Fundus photo; 848x848; nonmydriatic.
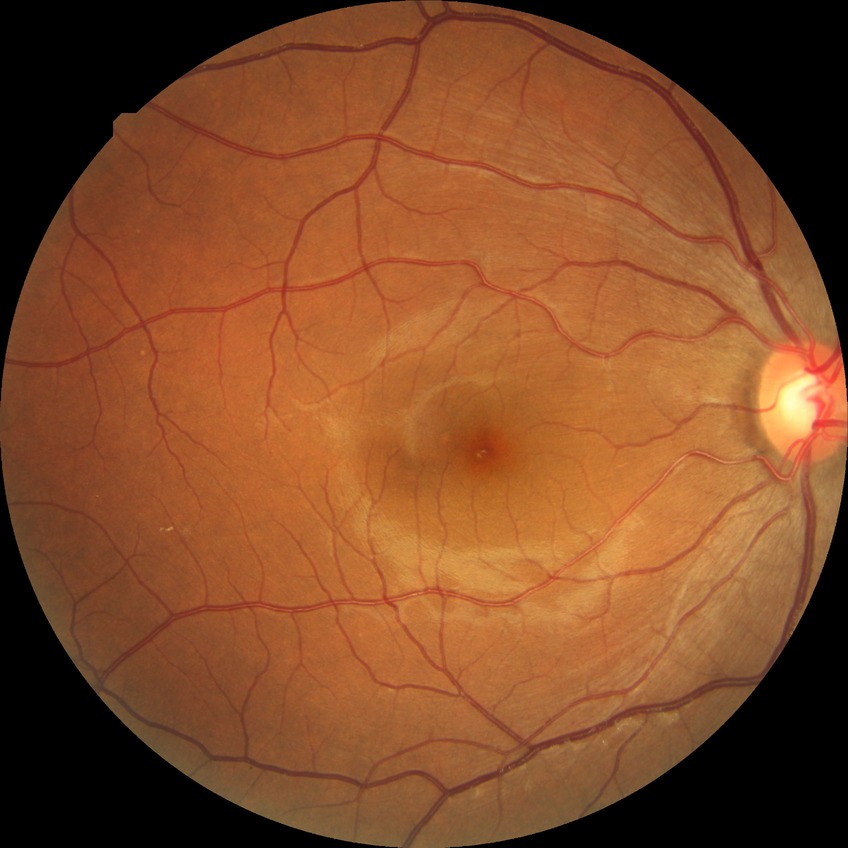
diabetic retinopathy (DR) = SDR (simple diabetic retinopathy).